Wide-field fundus image from infant ROP screening.
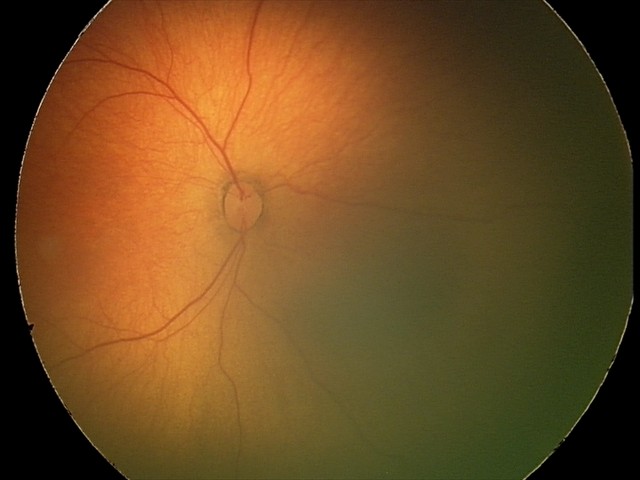

Impression = normal retinal appearance.